Diabetic retinopathy graded by the modified Davis classification, 848x848, acquired with a NIDEK AFC-230 — 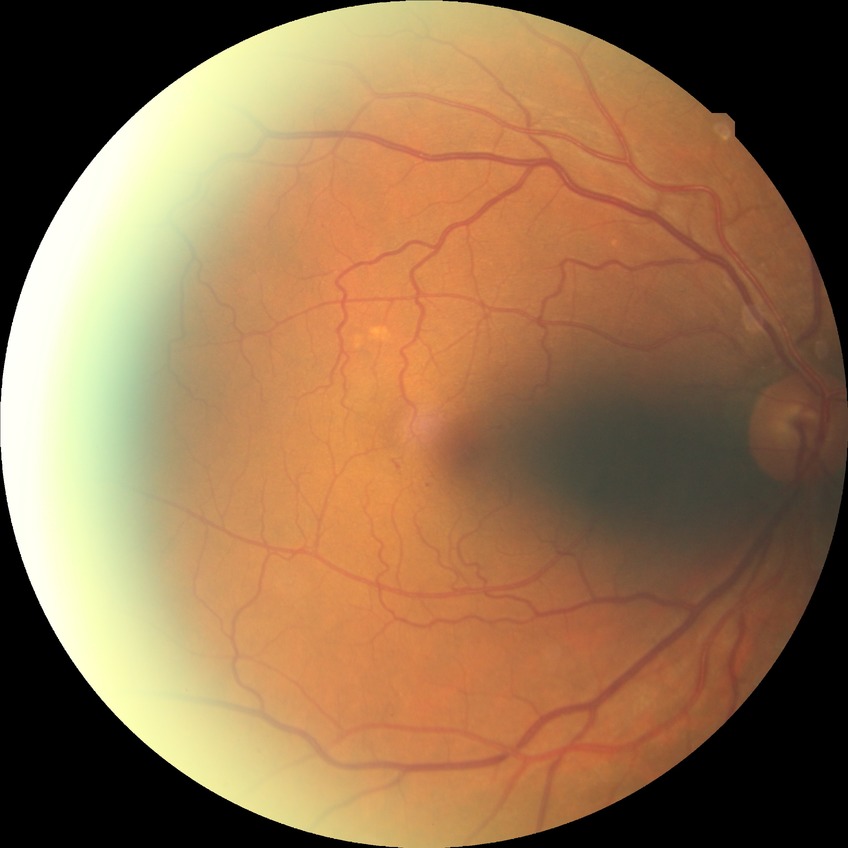
- diabetic retinopathy grade: no diabetic retinopathy